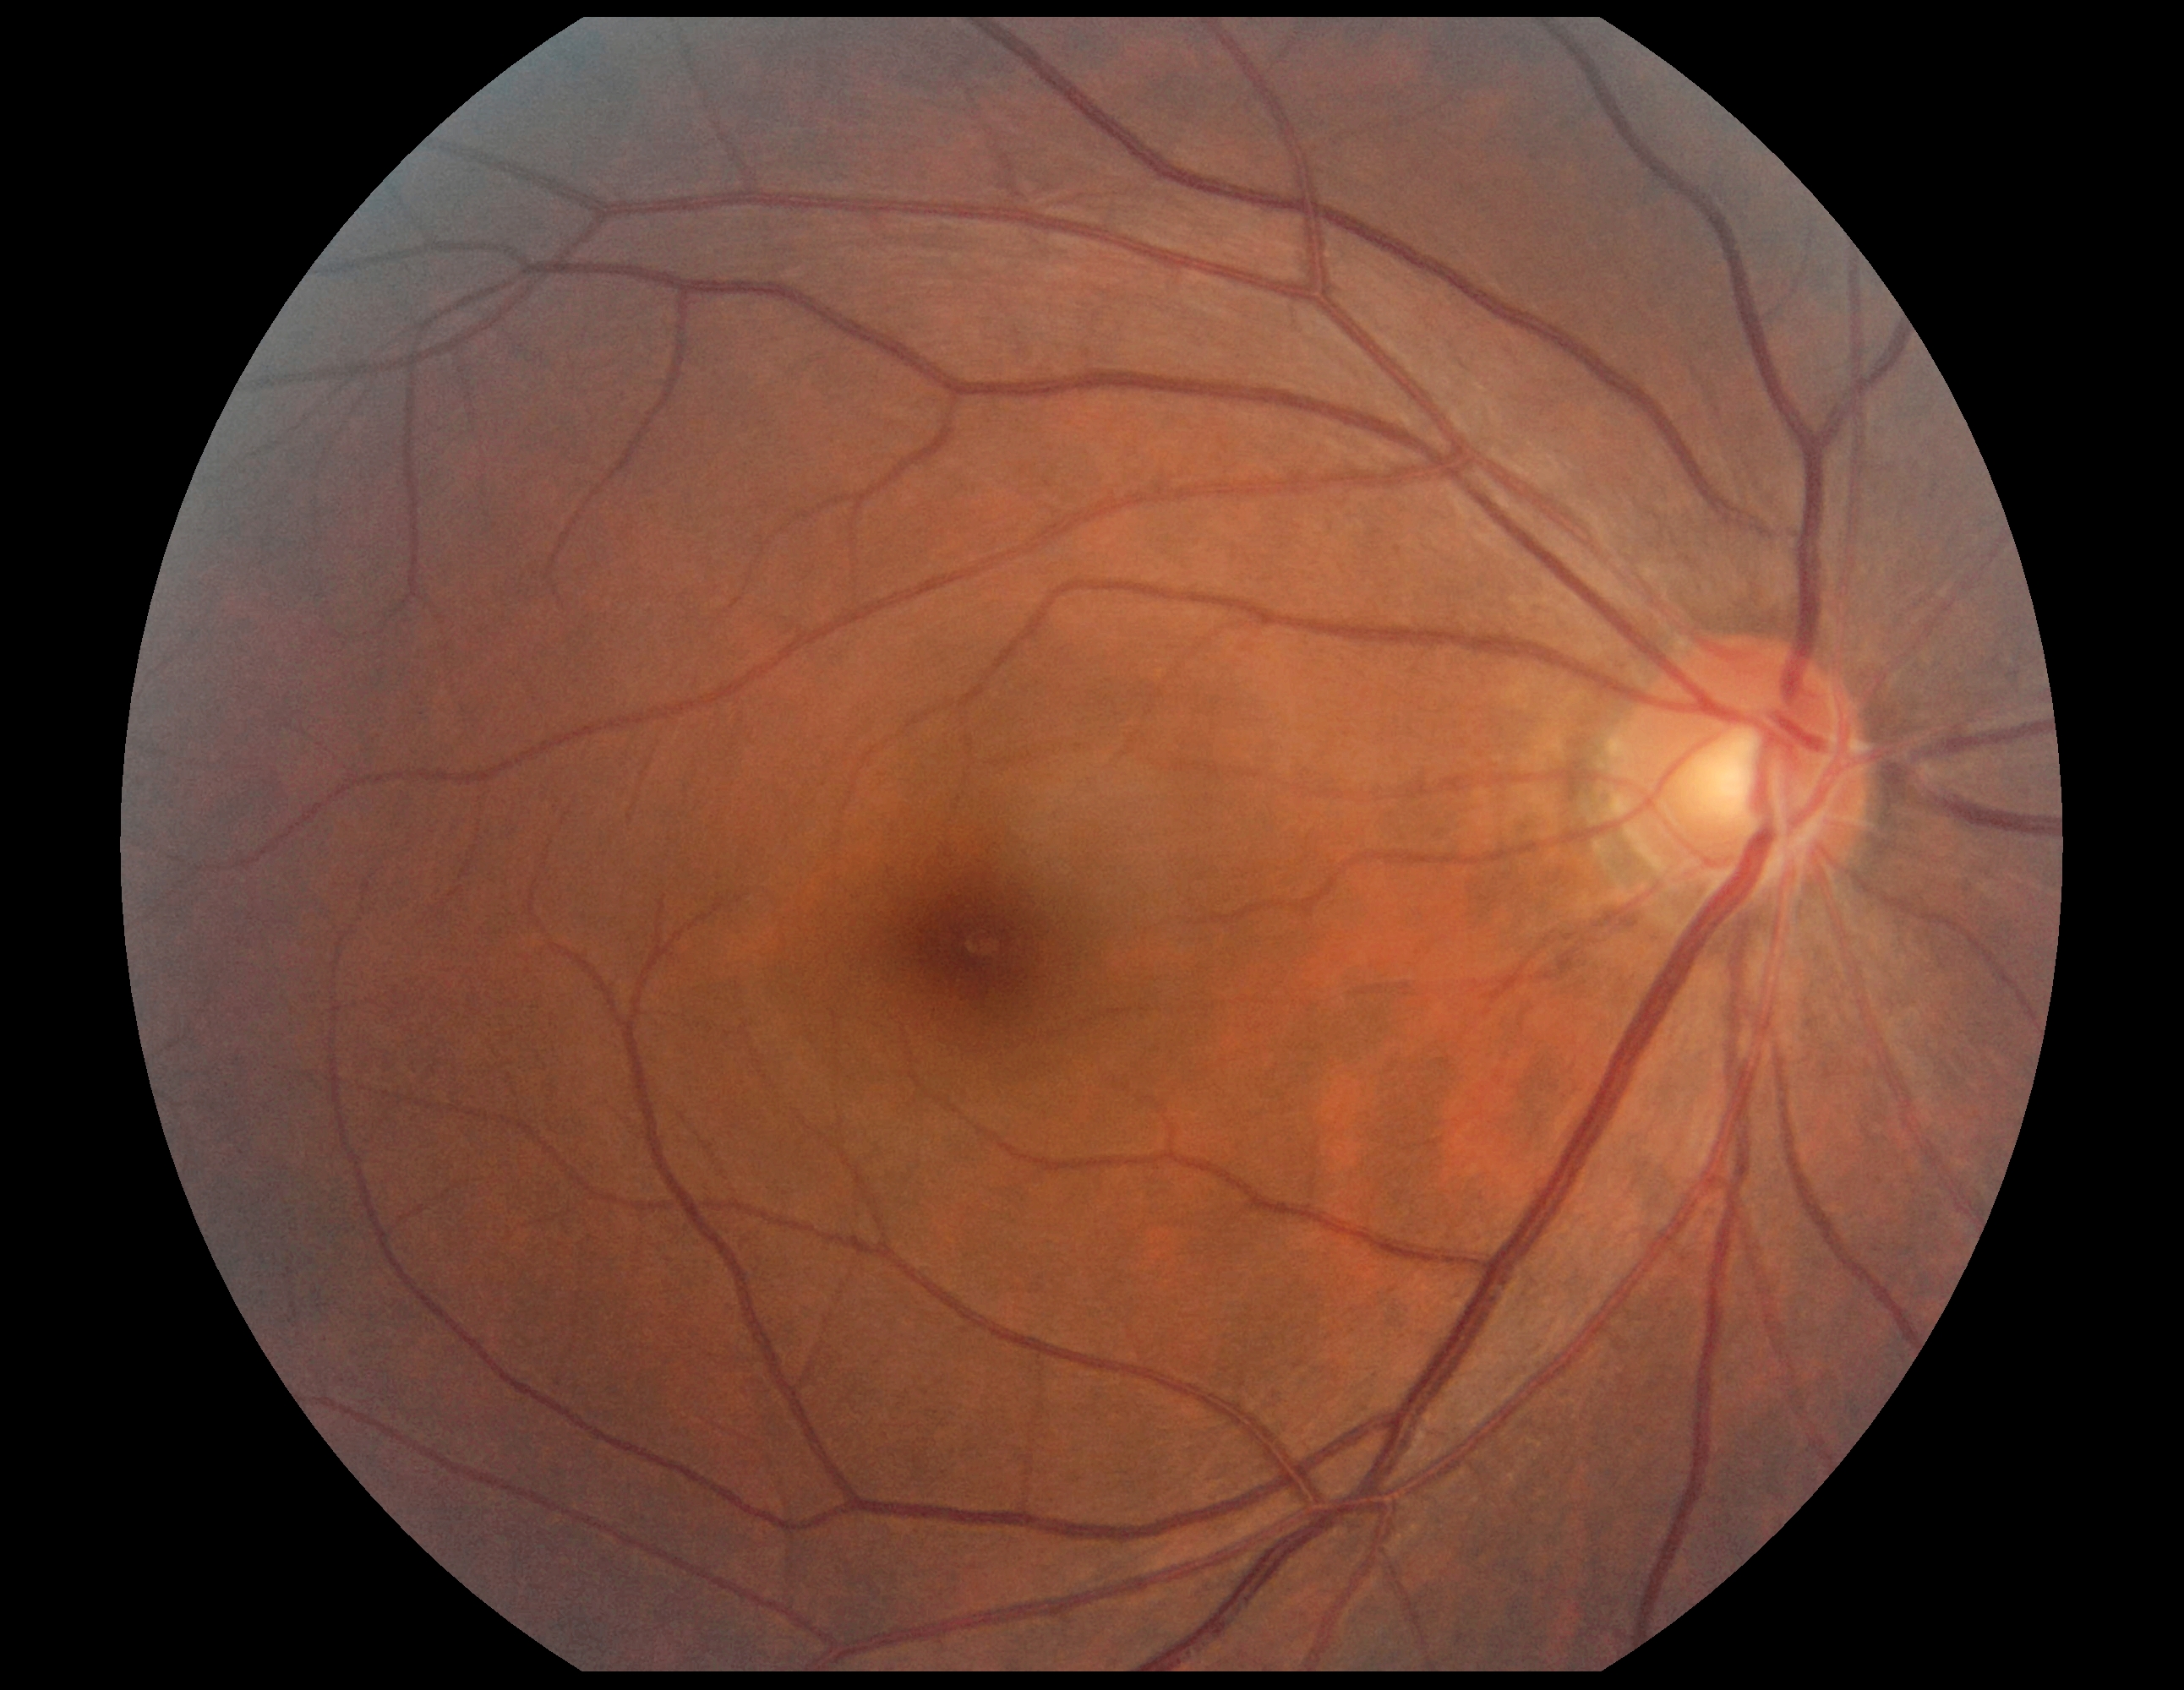
Annotations:
- DR severity — 0 — no visible signs of diabetic retinopathy